Non-mydriatic: 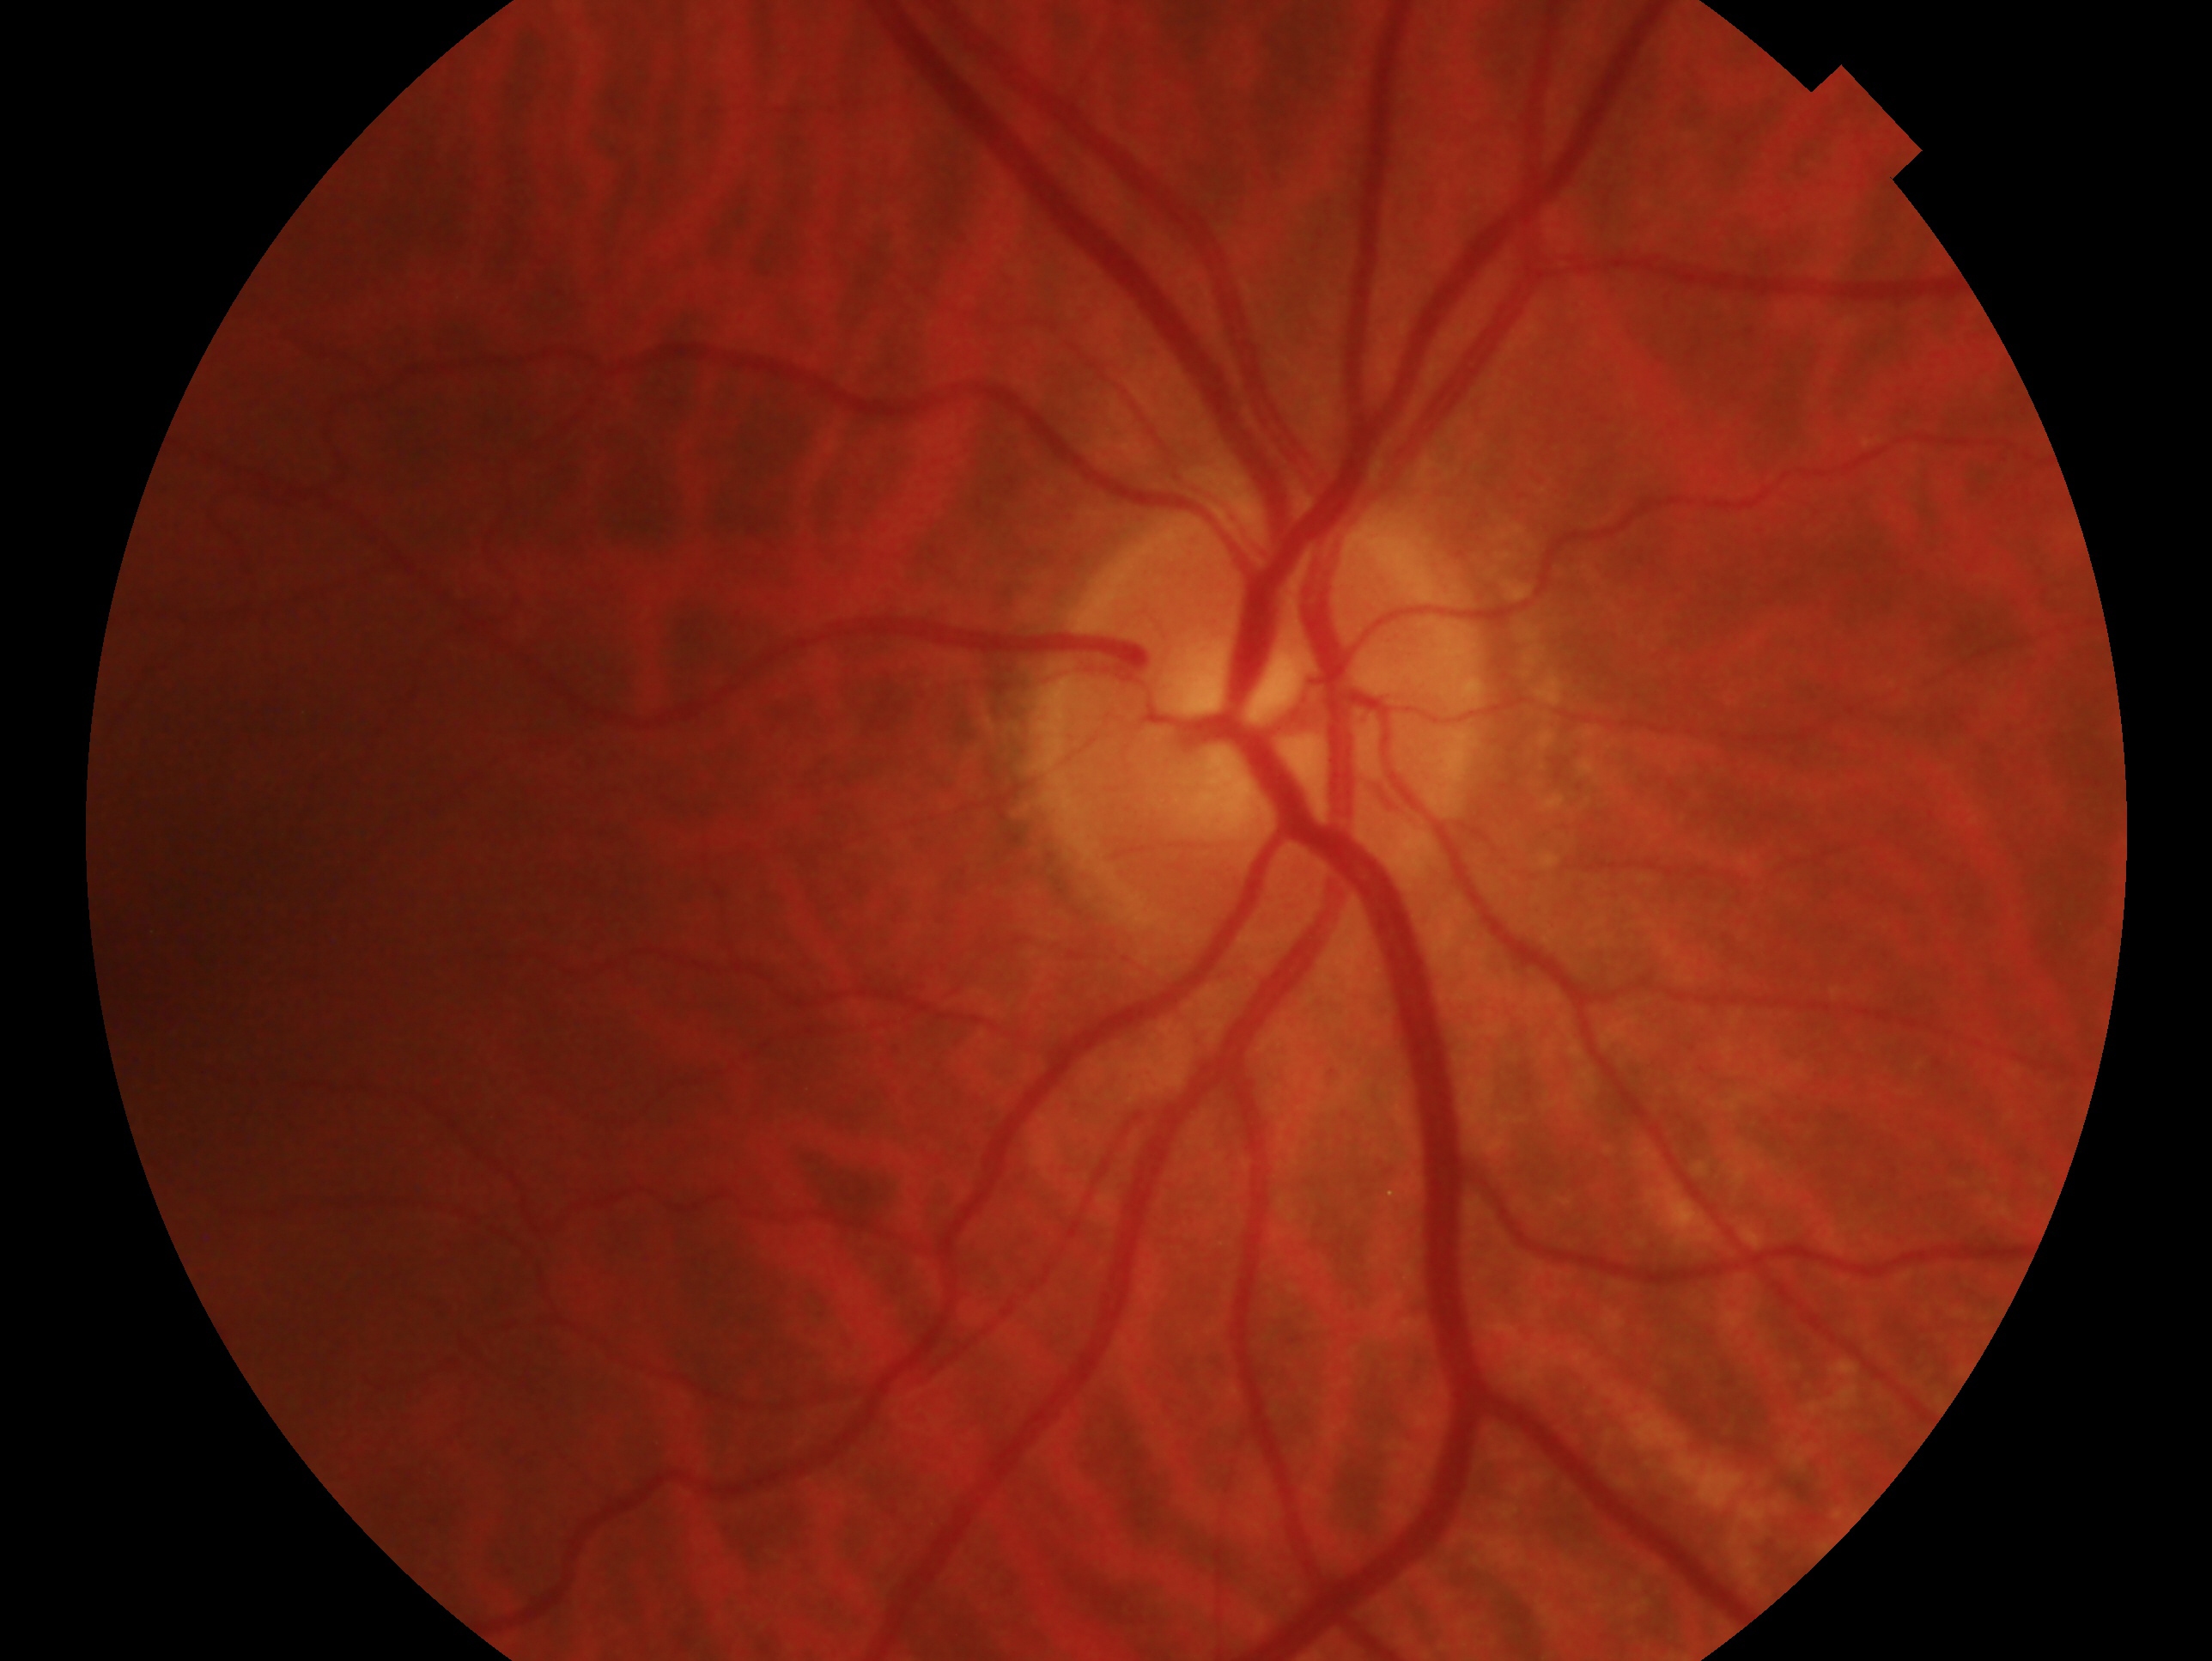
laterality = right eye | impression = no evidence of glaucoma.